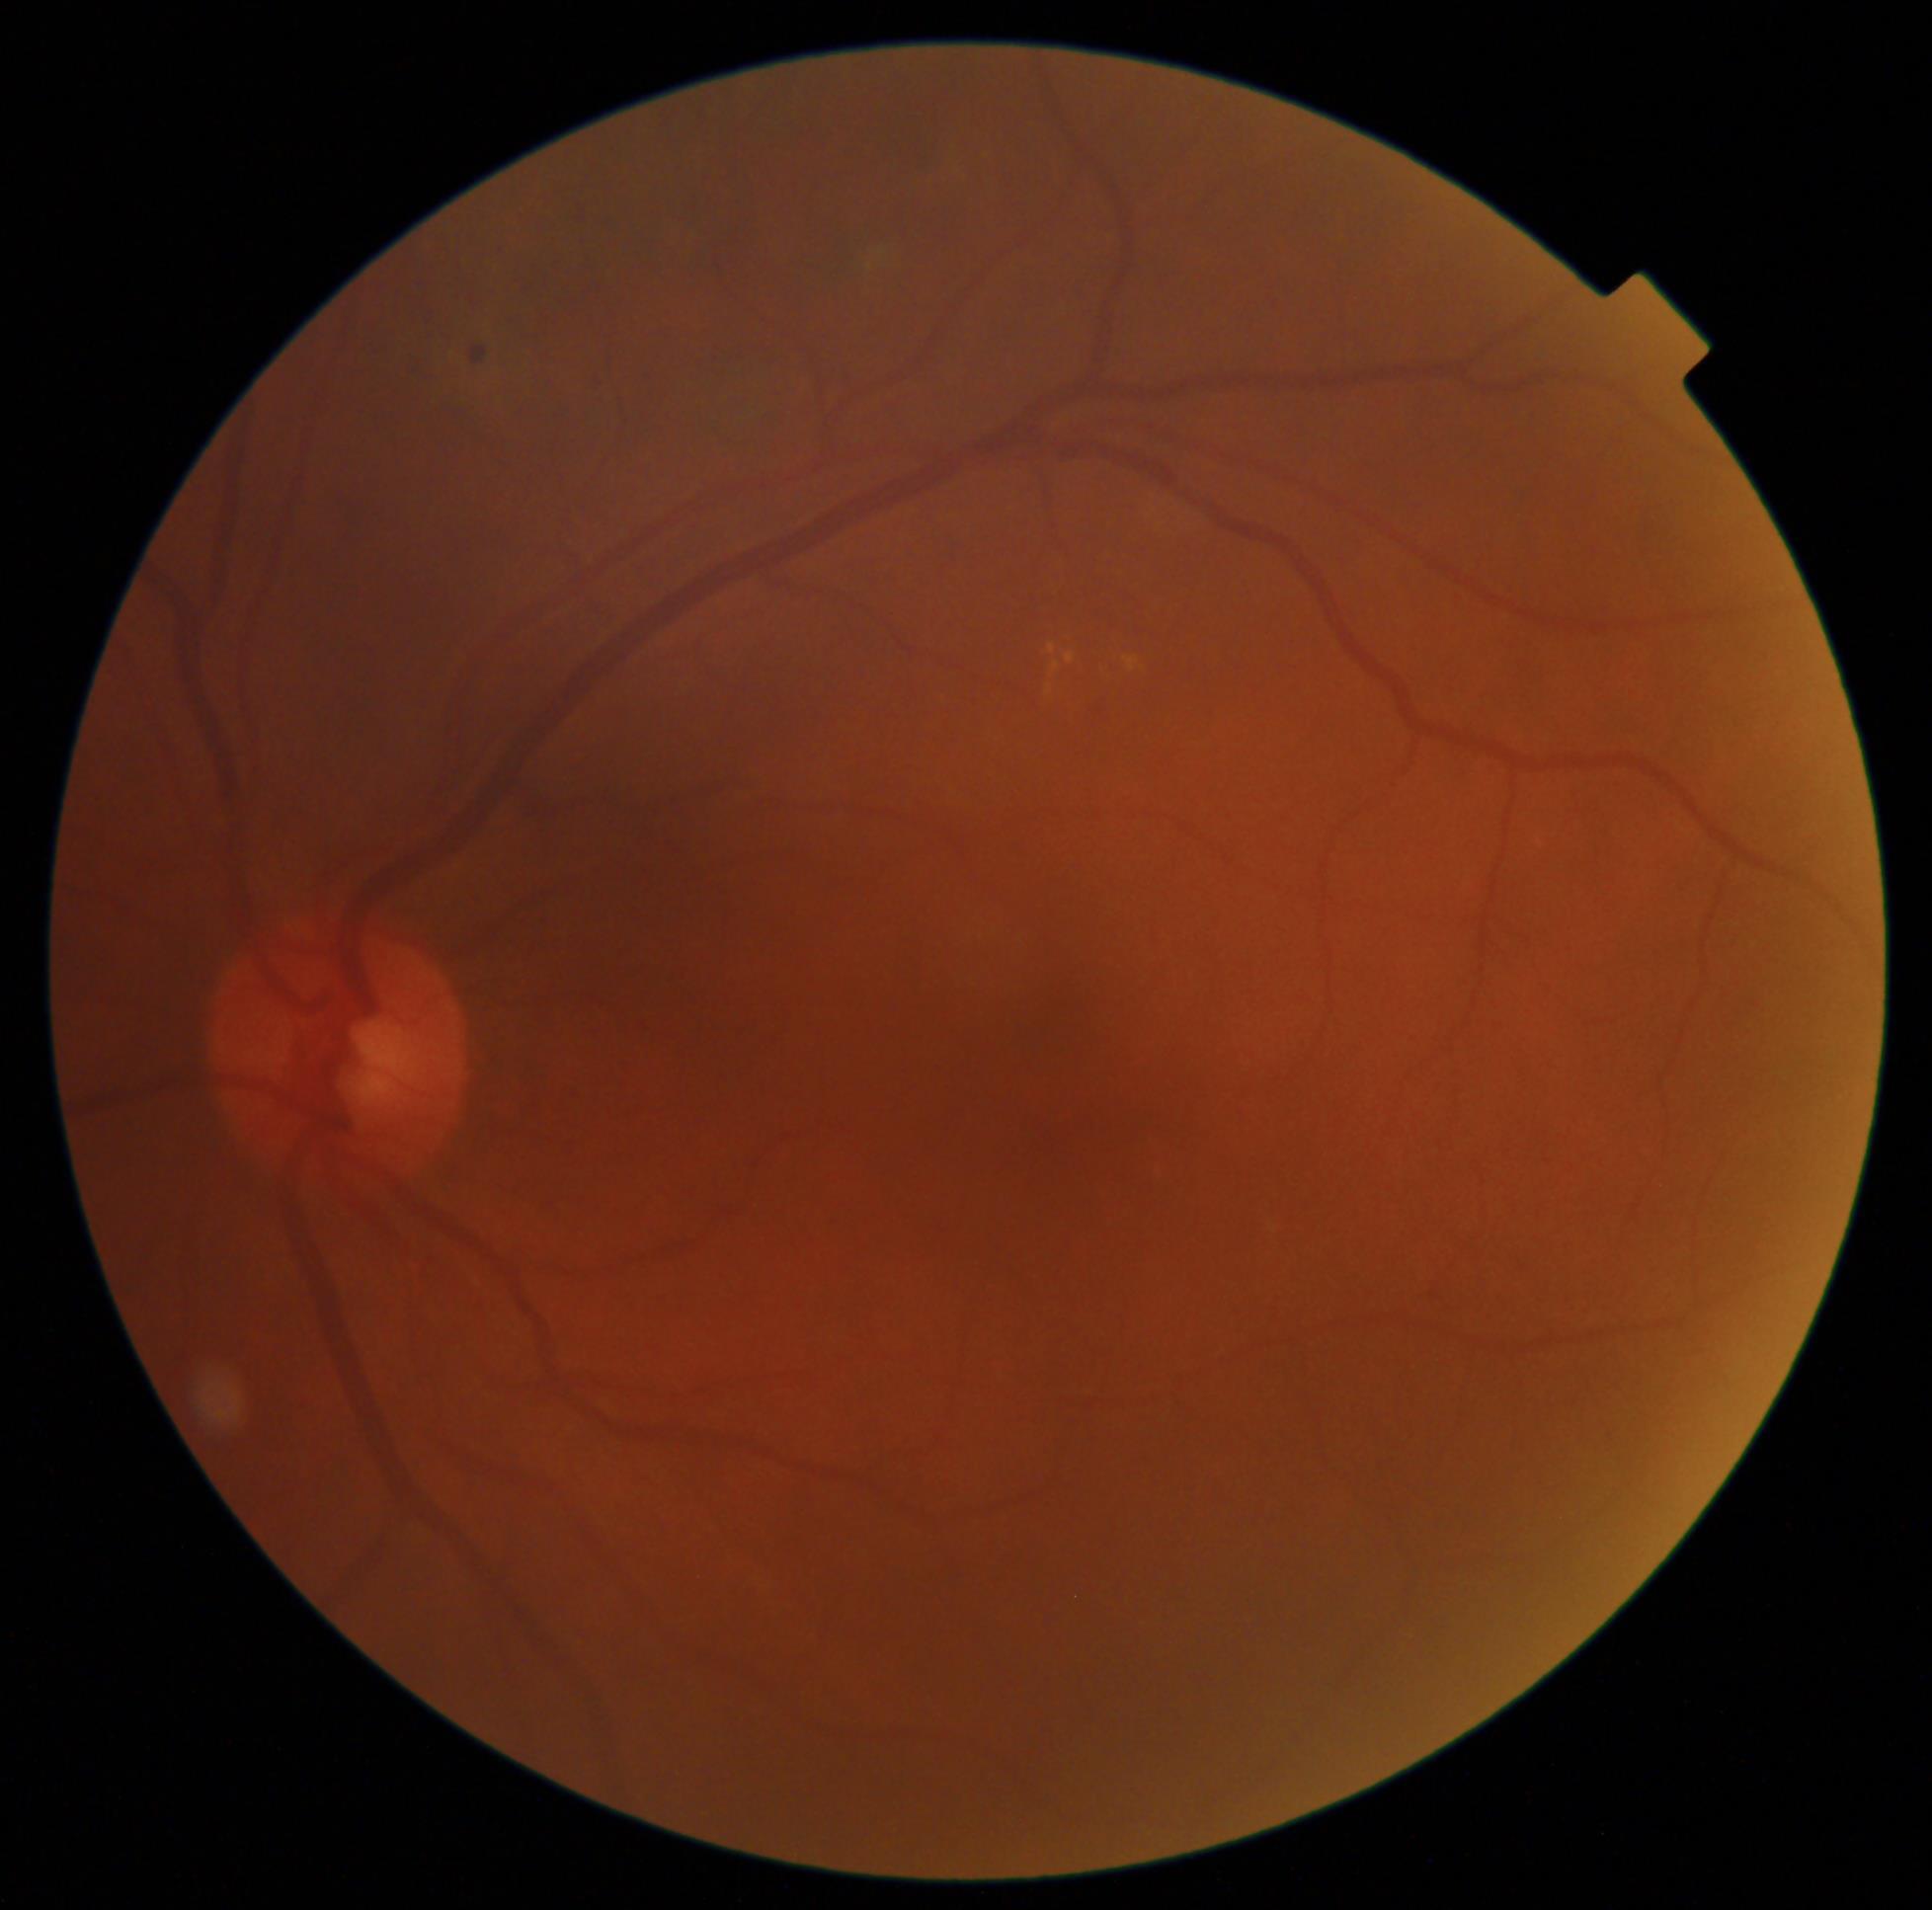
DR severity: moderate non-proliferative diabetic retinopathy (grade 2).